Image size 2184x1690: 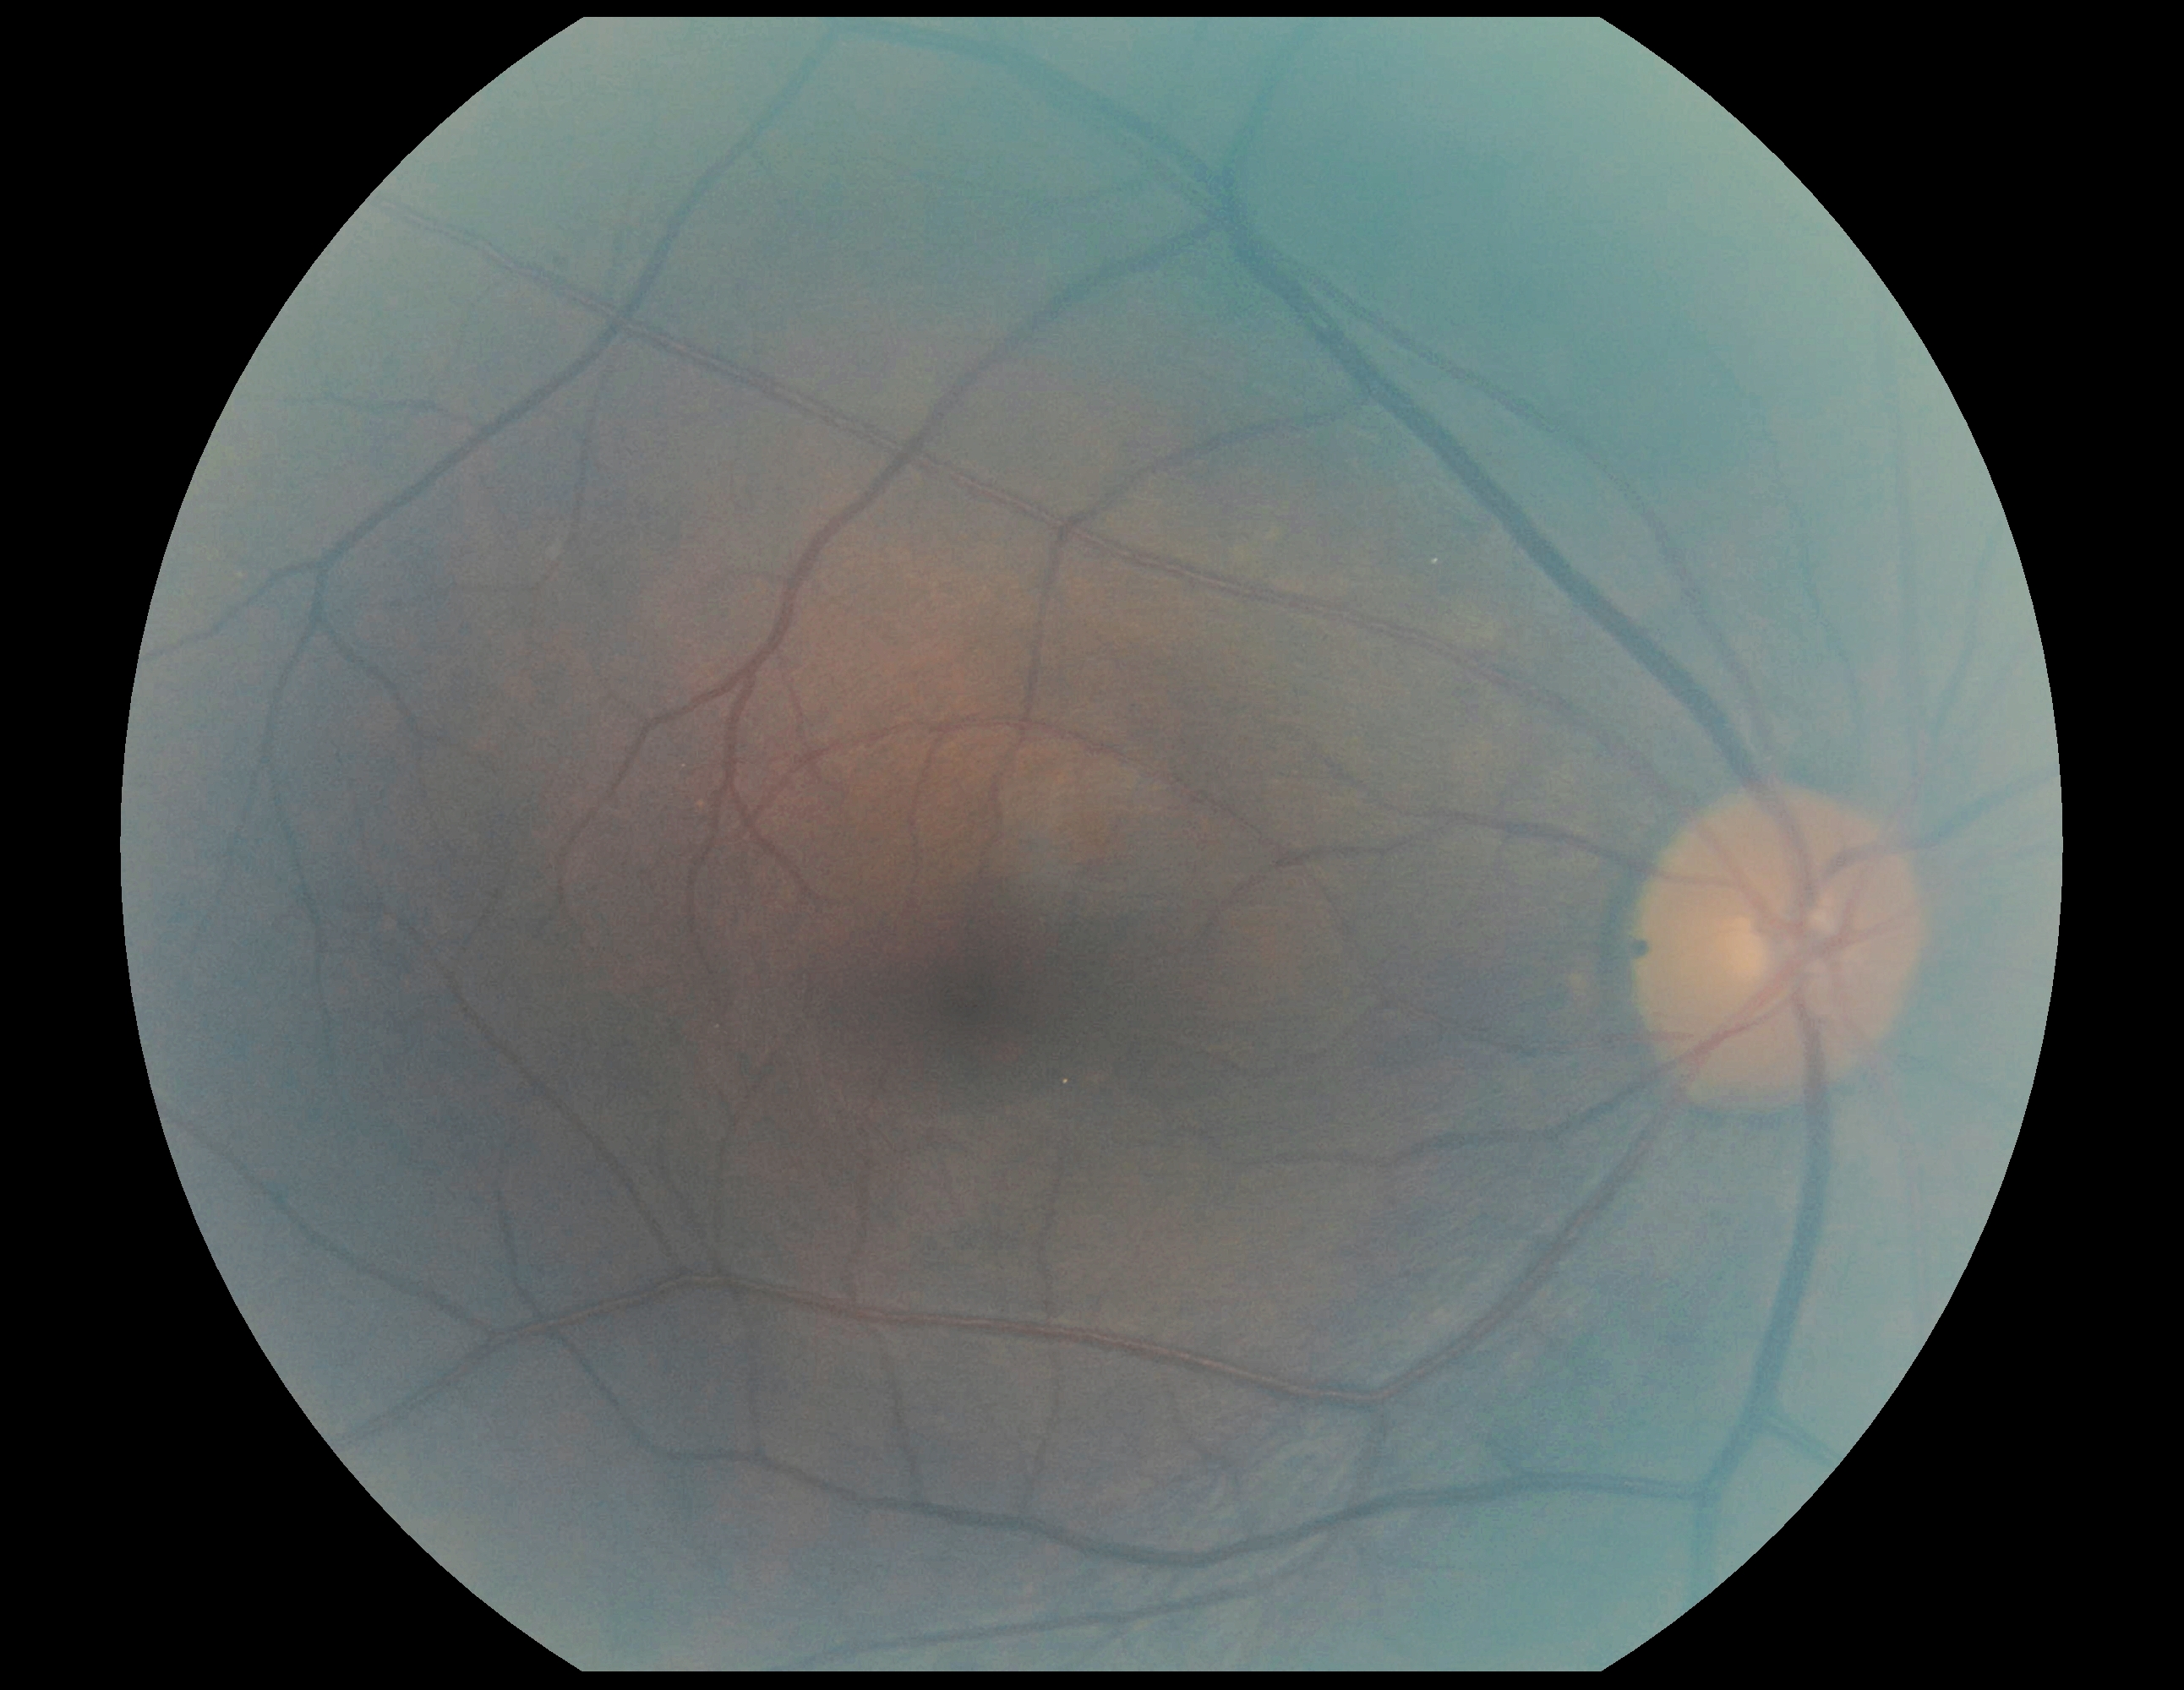

Annotations:
* retinopathy grade: no apparent retinopathy (0)
* DR impression: no signs of DR